Pediatric wide-field fundus photograph. 130° field of view (Natus RetCam Envision)
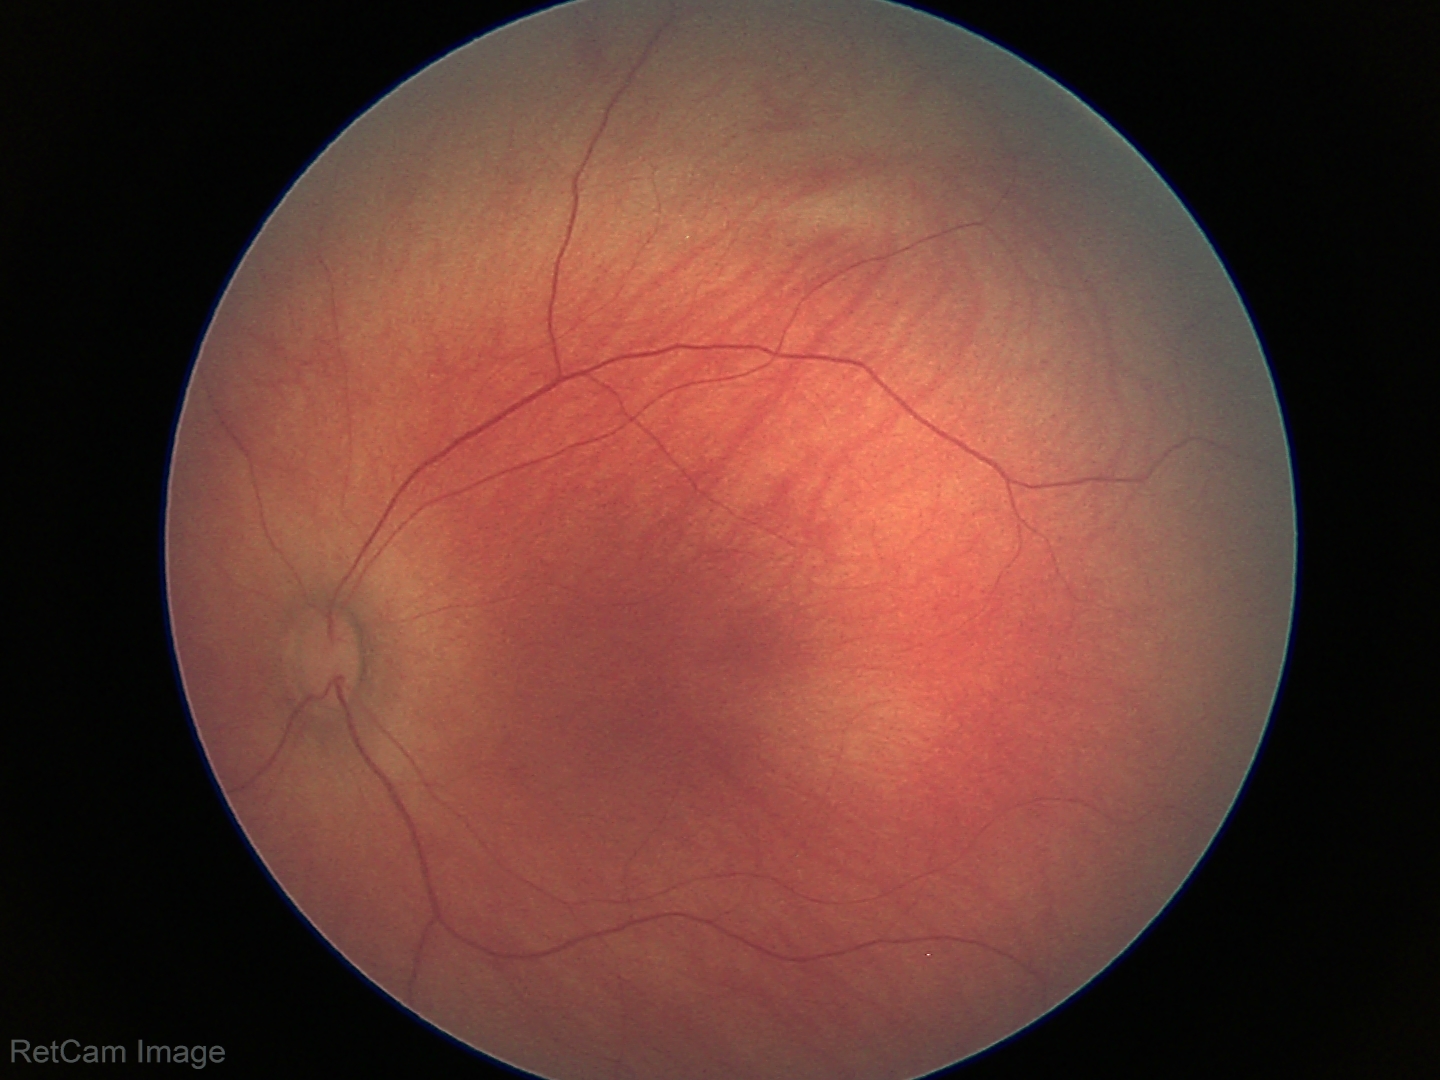 Screening examination diagnosed as physiological.